Camera: Clarity RetCam 3 (130° FOV); infant wide-field retinal image.
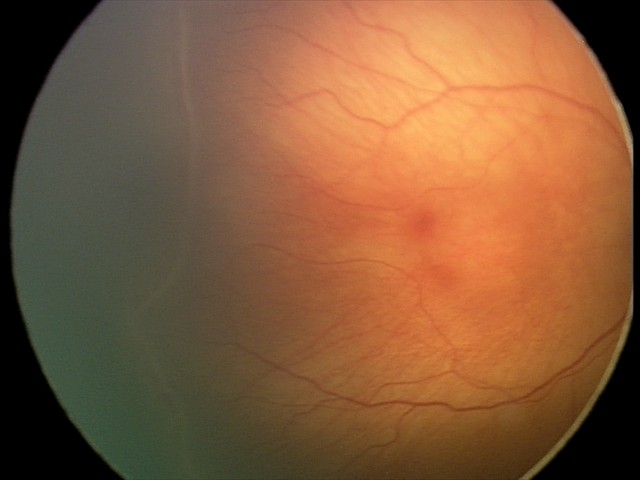

Plus disease = absent, impression = retinopathy of prematurity stage 2 — ridge with height and width at the demarcation line.